2352 x 1568 pixels. FOV: 45 degrees. Retinal fundus photograph
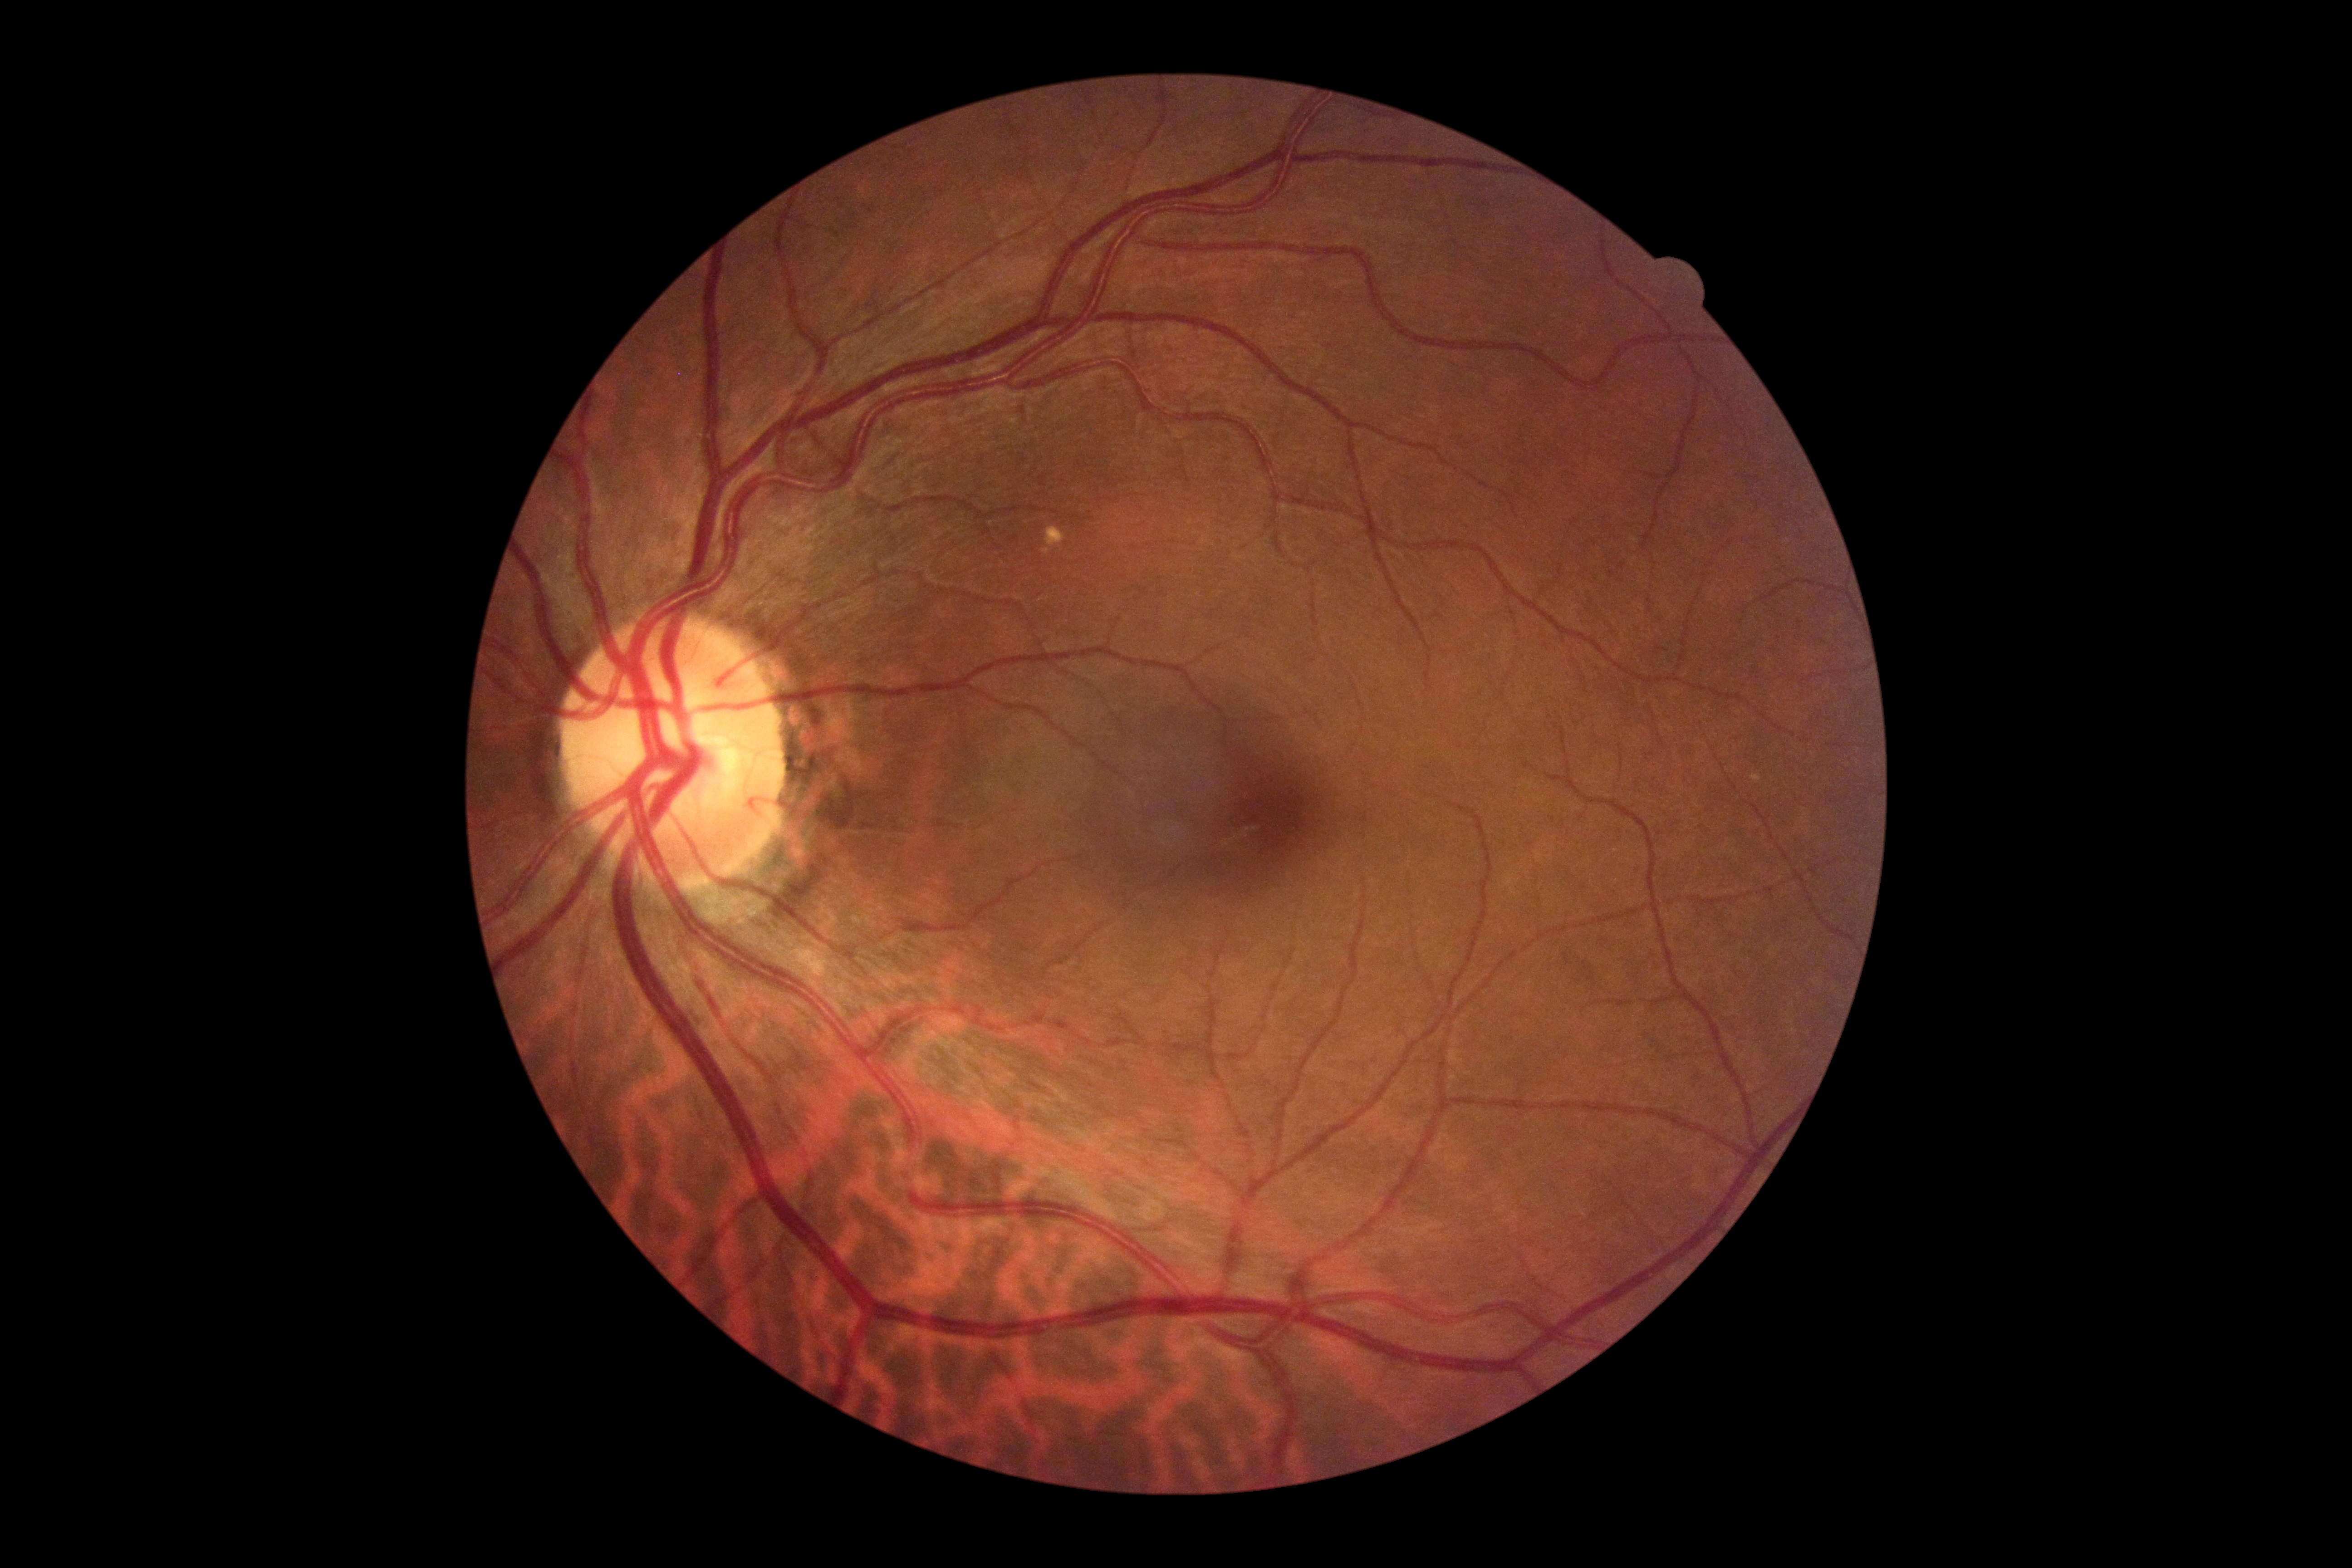
Diabetic retinopathy grade is 0 — no visible signs of diabetic retinopathy.